Wide-field contact fundus photograph of an infant — 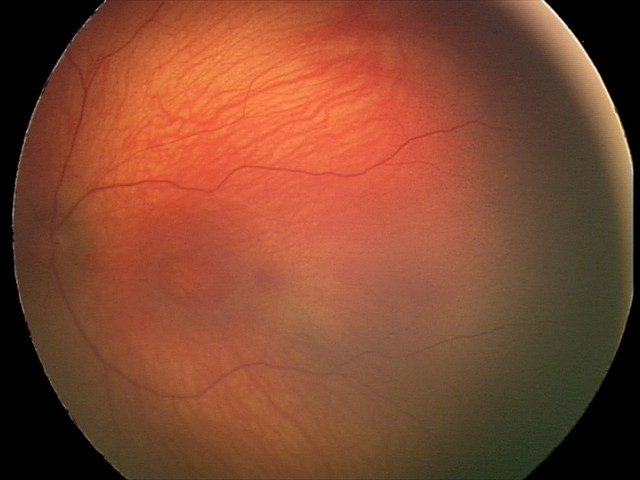 Screening examination with no abnormal retinal findings.